240 by 240 pixels. Non-mydriatic acquisition:
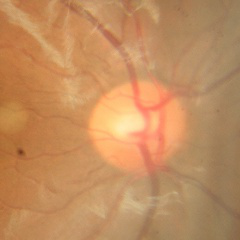

Glaucoma assessment: no glaucoma.